CFP
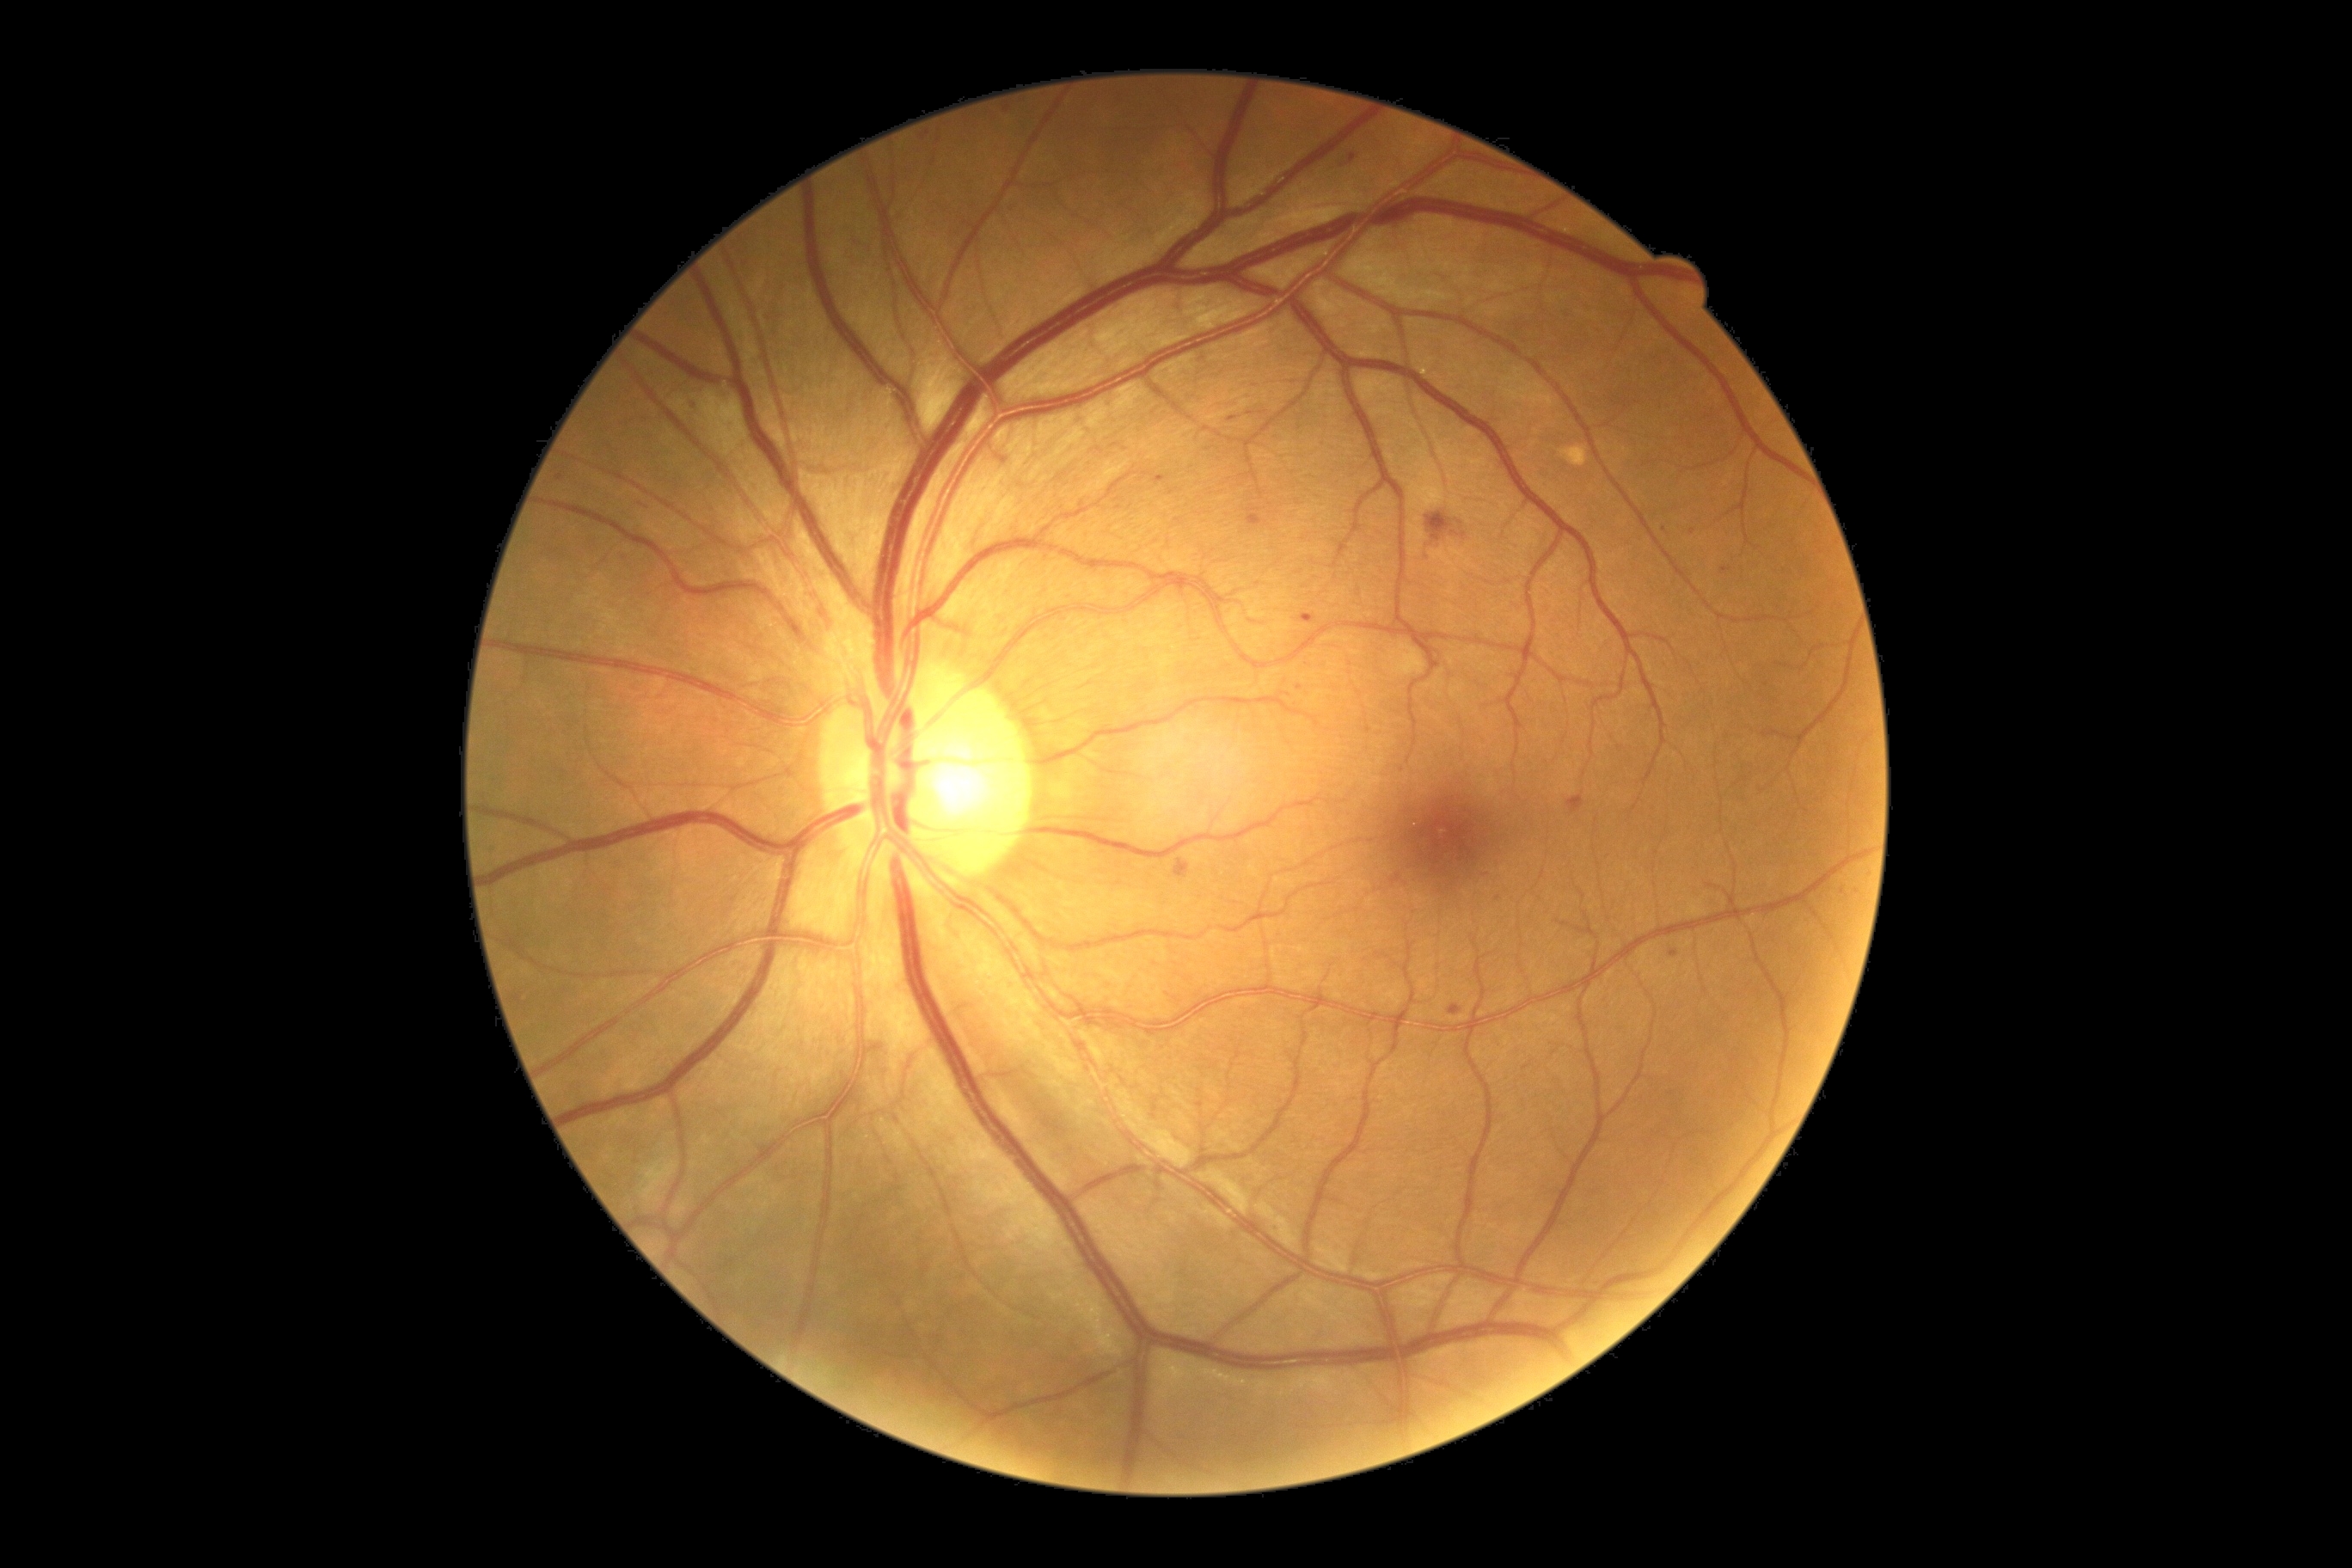 {"dr_grade": 2, "dr_grade_name": "moderate NPDR", "lesions": {"he": [[1175, 859, 1191, 879], [1567, 795, 1584, 816], [1424, 515, 1464, 568]], "ma": [[1349, 154, 1356, 164], [1720, 567, 1732, 573], [1227, 415, 1239, 422], [922, 133, 931, 140], [1449, 1005, 1464, 1015], [1670, 950, 1679, 957], [1155, 475, 1170, 484], [1301, 615, 1316, 623], [1392, 874, 1400, 886], [1247, 506, 1265, 527]], "ma_small_centers": [[1665, 530], [1692, 532], [1008, 110], [559, 478], [1498, 899]], "ex": null, "se": null}}